Optic disc region of a color fundus photo — 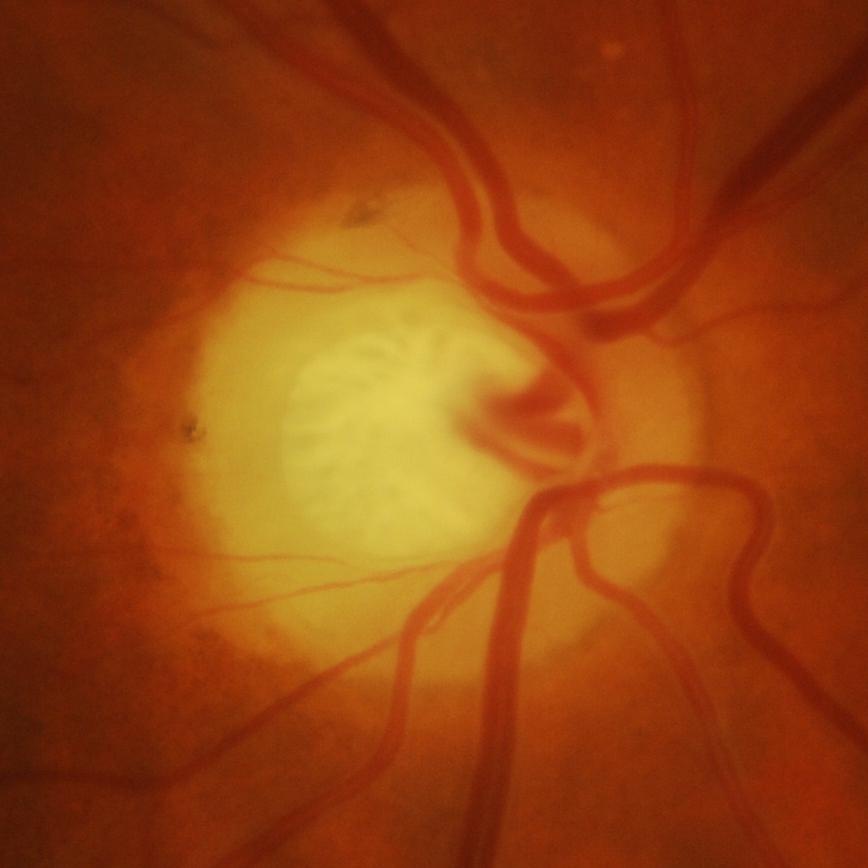
Finding: glaucoma.